2048 x 1536 pixels.
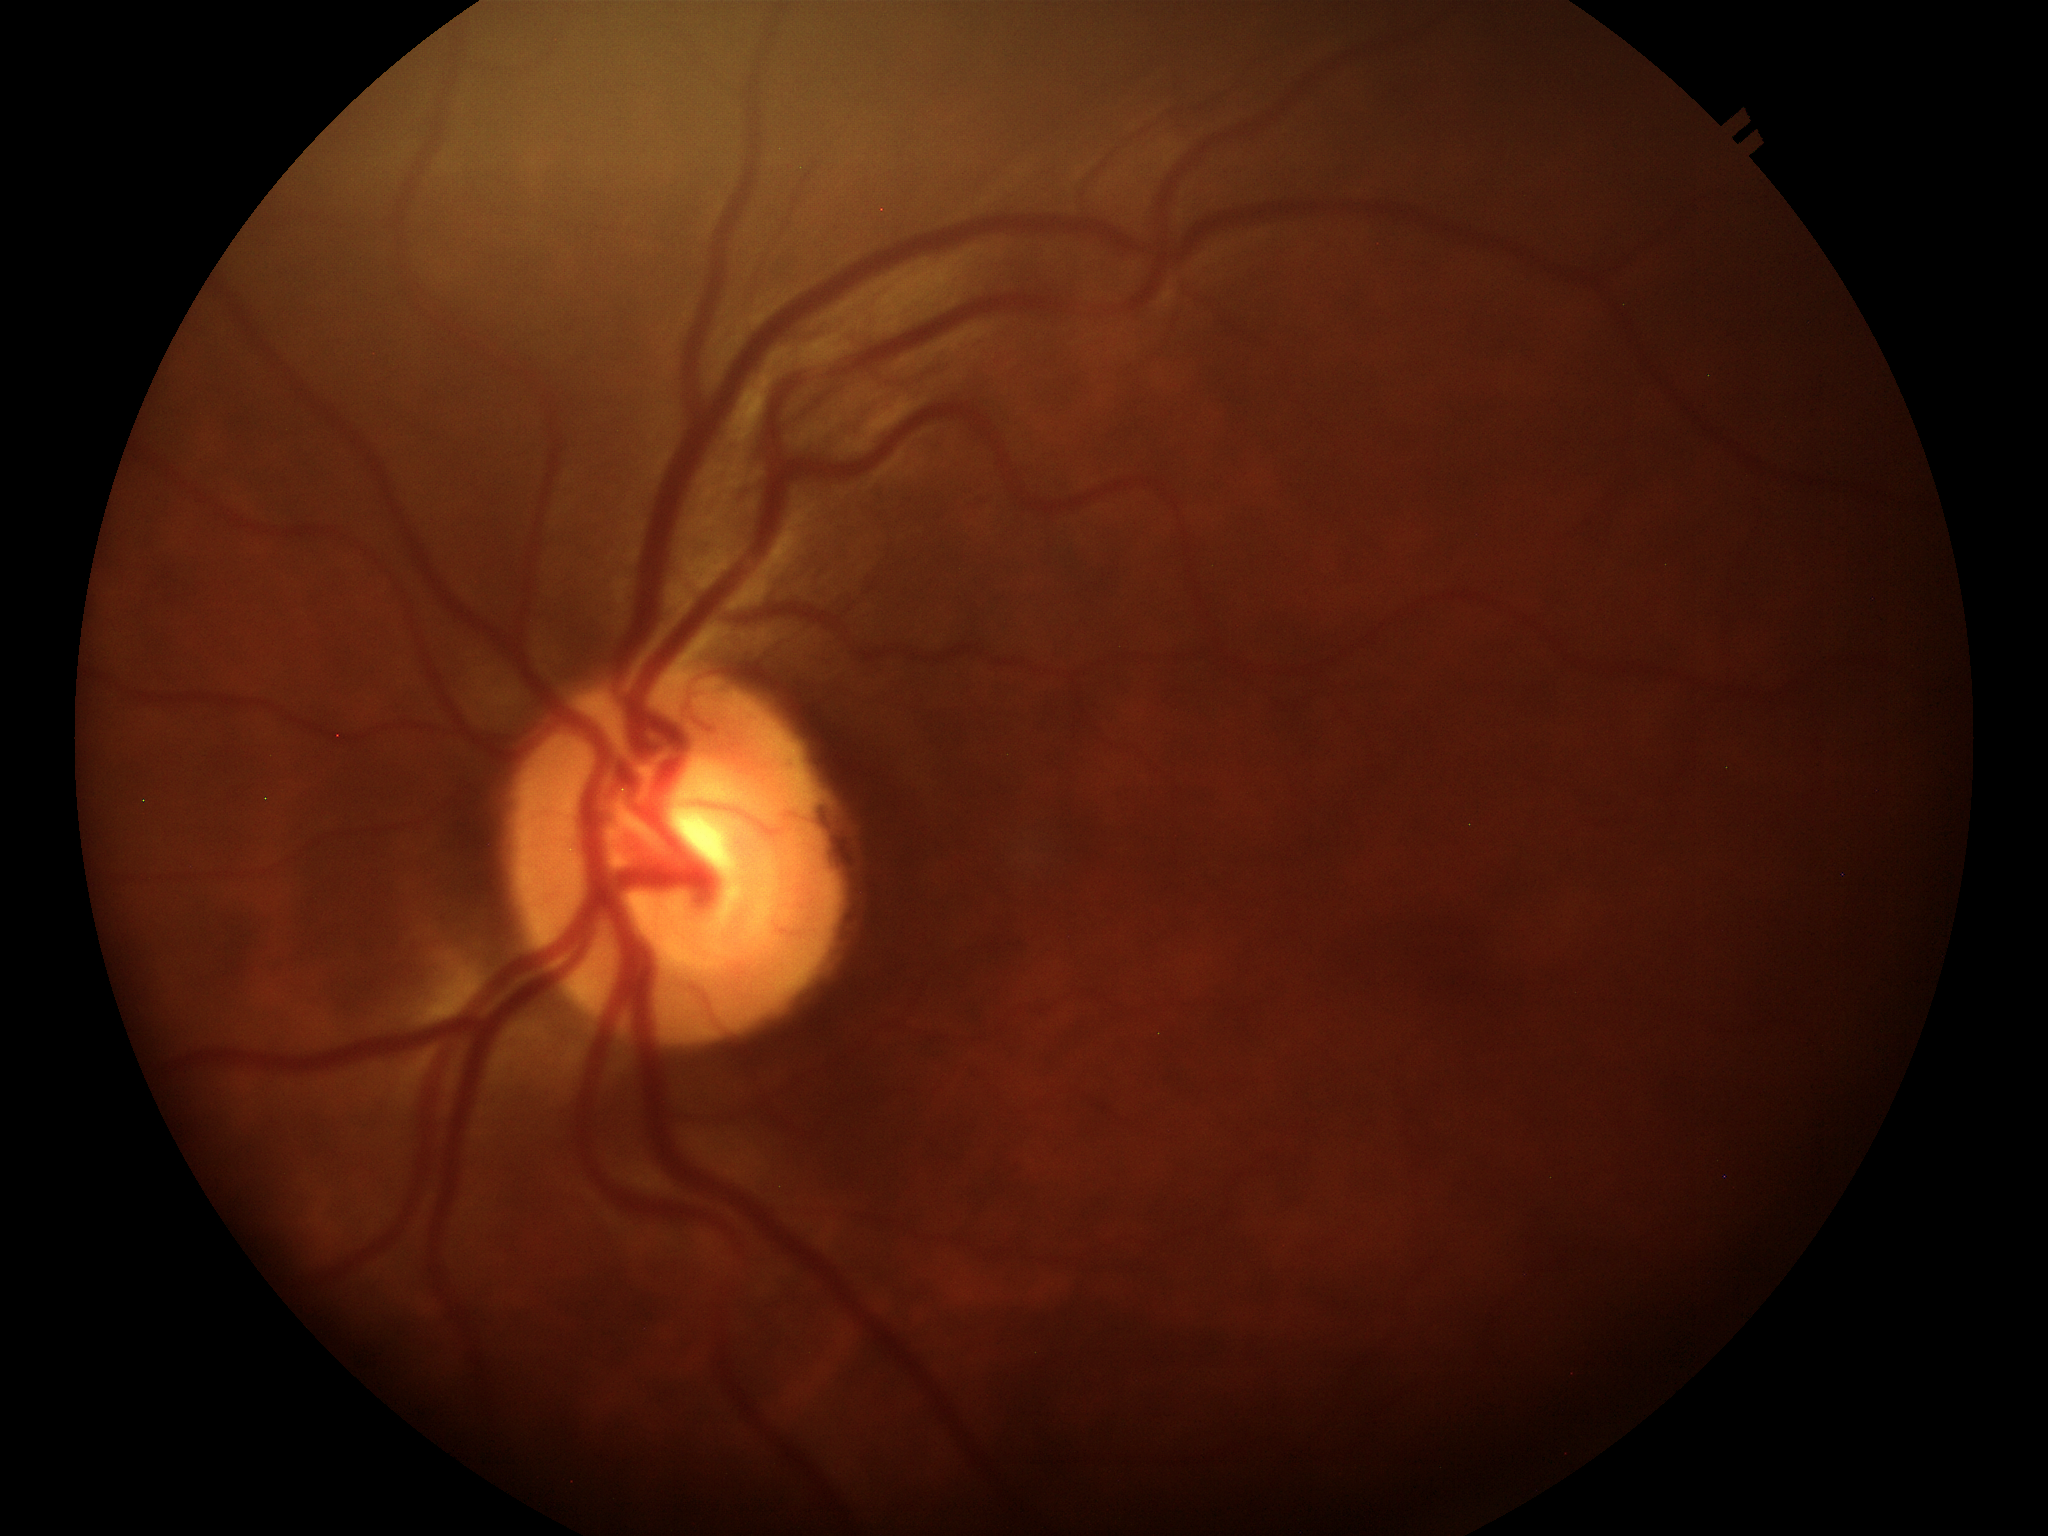

Not suspicious for glaucoma (2/5 graders called glaucoma suspect).
Horizontal C/D ratio (HCDR): 0.55.
Vertical cup-disc ratio (VCDR) is 0.55.